50° FOV, captured on a Topcon TRC-50DX fundus camera.
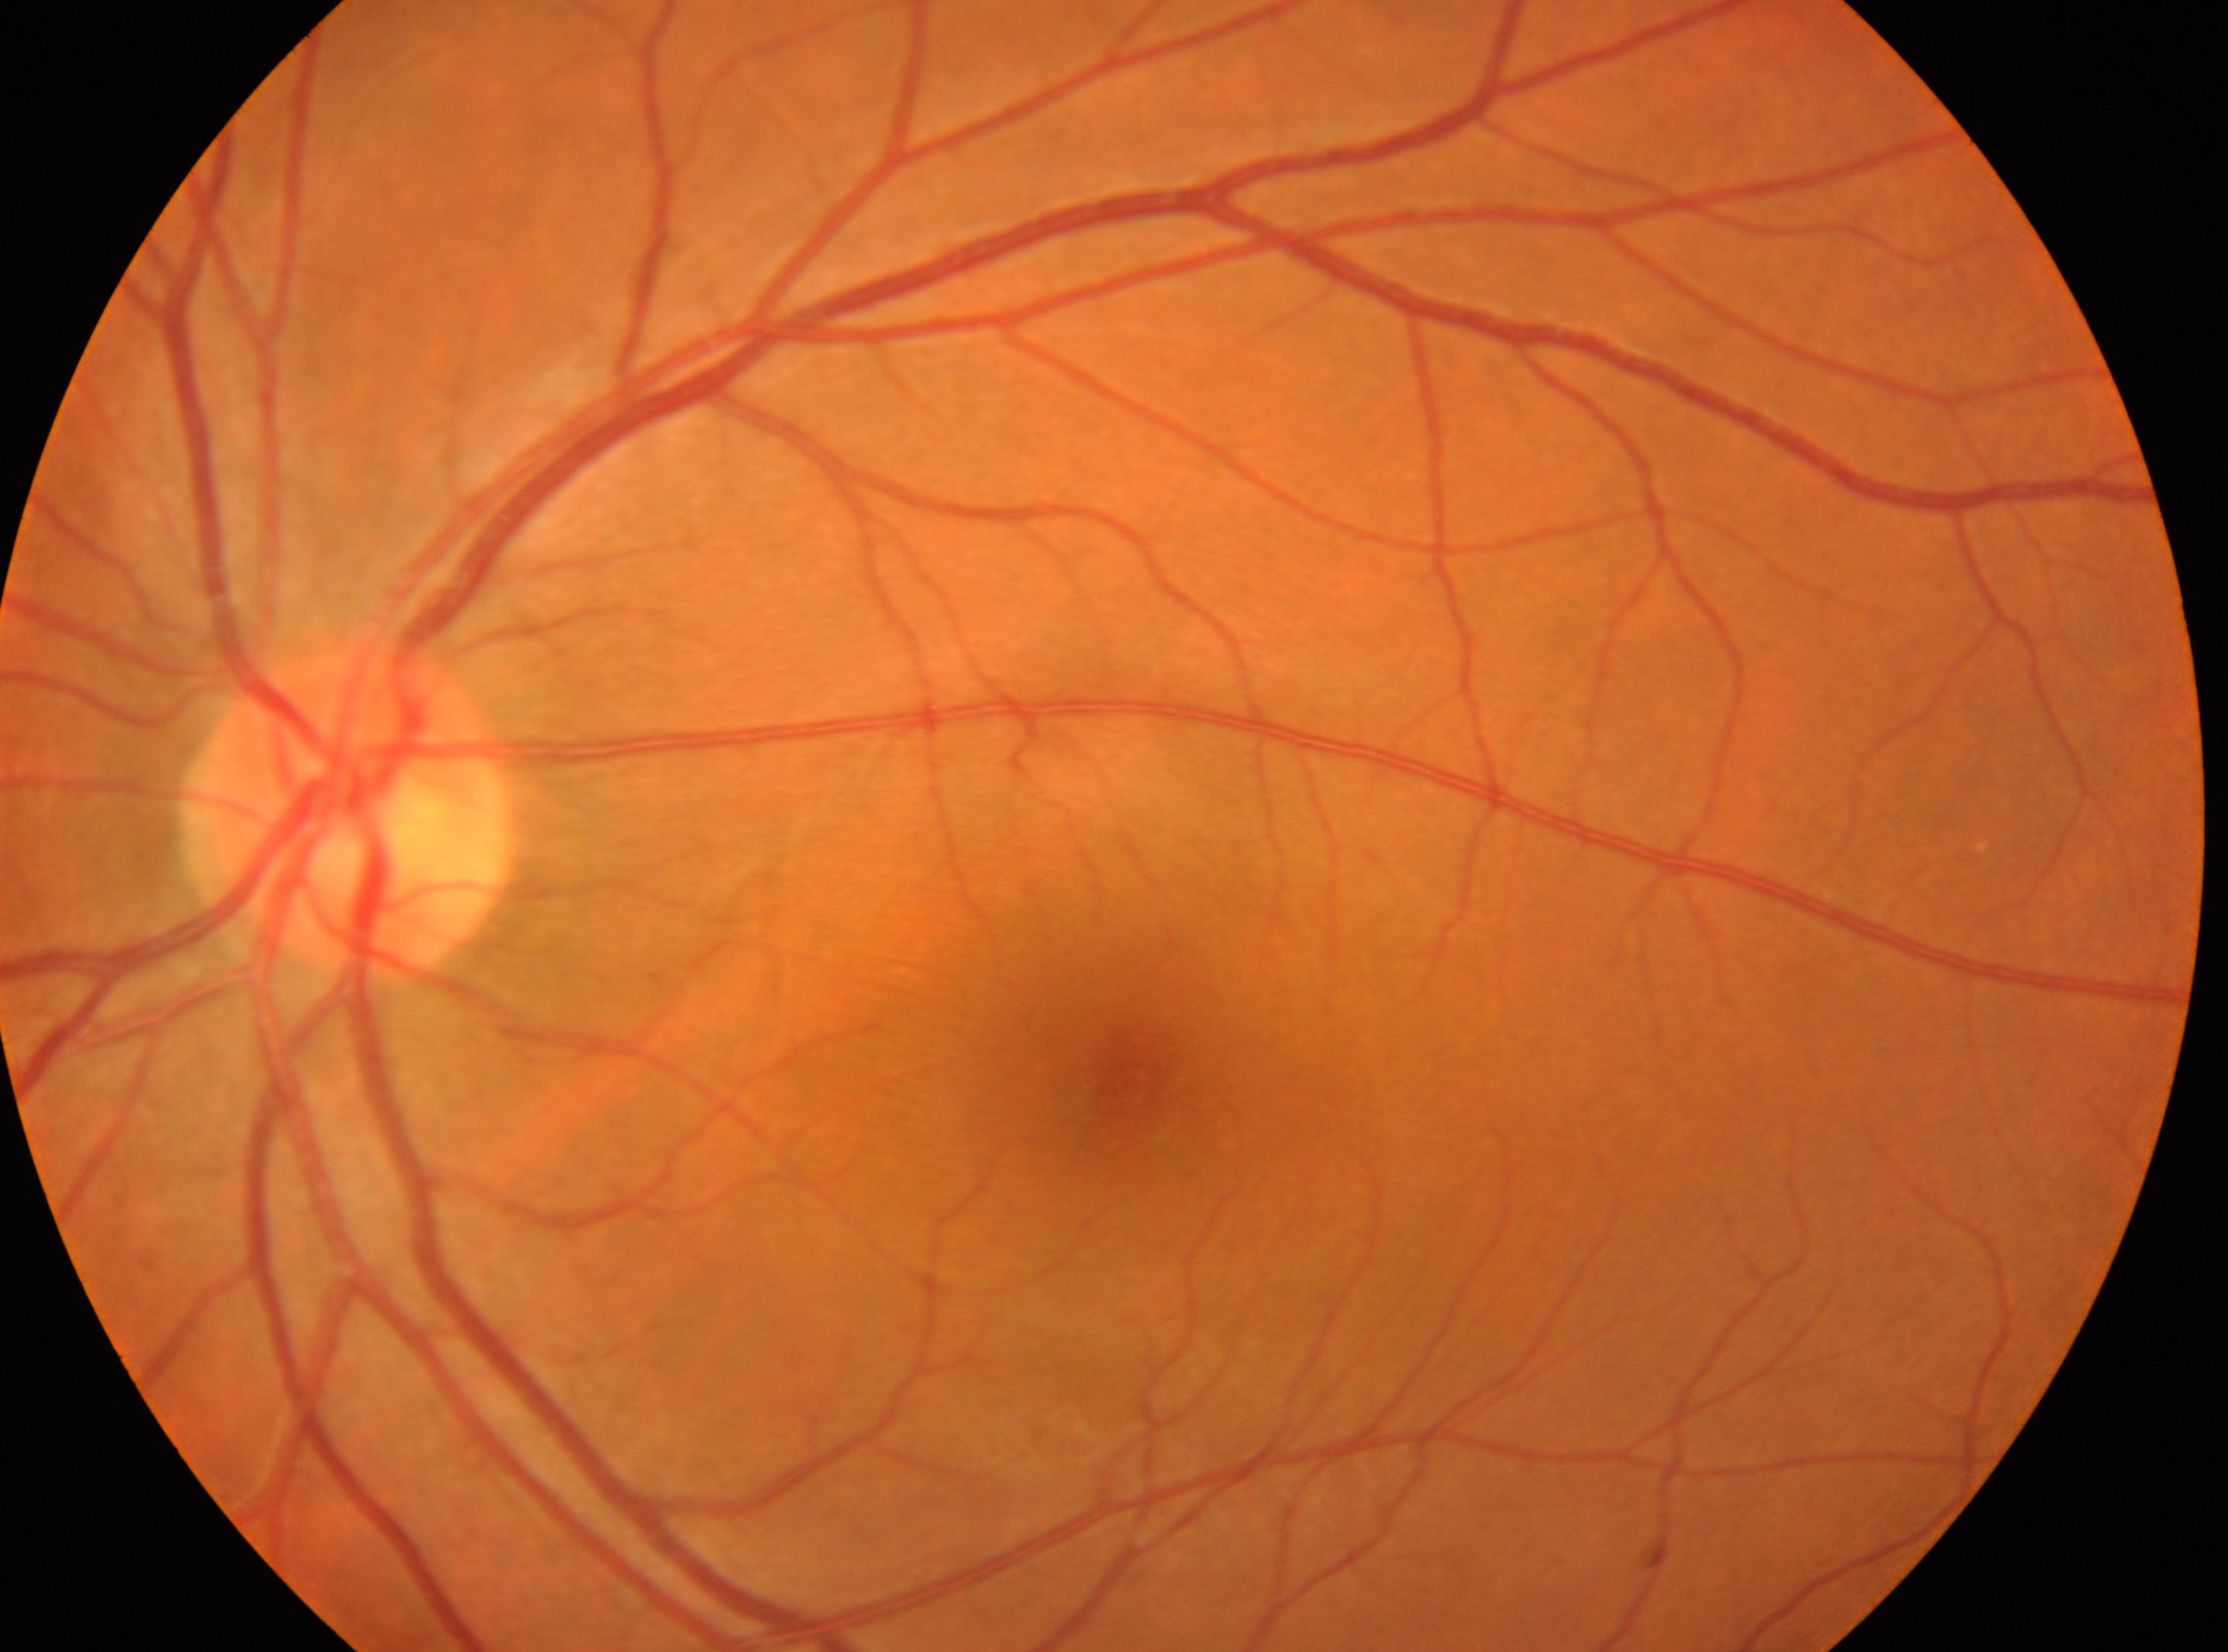

This is the left eye. Macula center: (1128, 1083). Optic disc located at (348, 805). DR: no apparent diabetic retinopathy (grade 0) — no visible signs of diabetic retinopathy.